457 by 457 pixels, color fundus photograph centered on the optic disc:
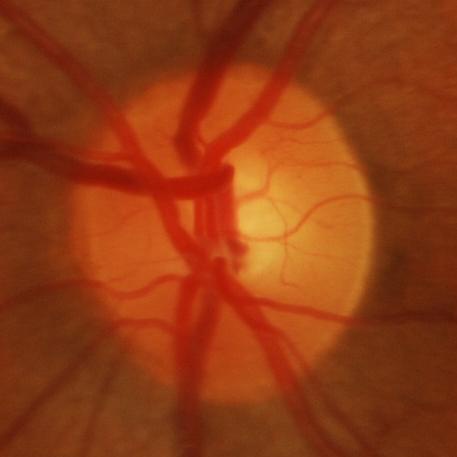 Glaucomatous optic neuropathy is present. Glaucoma assessment = glaucomatous damage to the optic nerve.